Acquired on the Phoenix ICON · infant wide-field retinal image · 1240x1240:
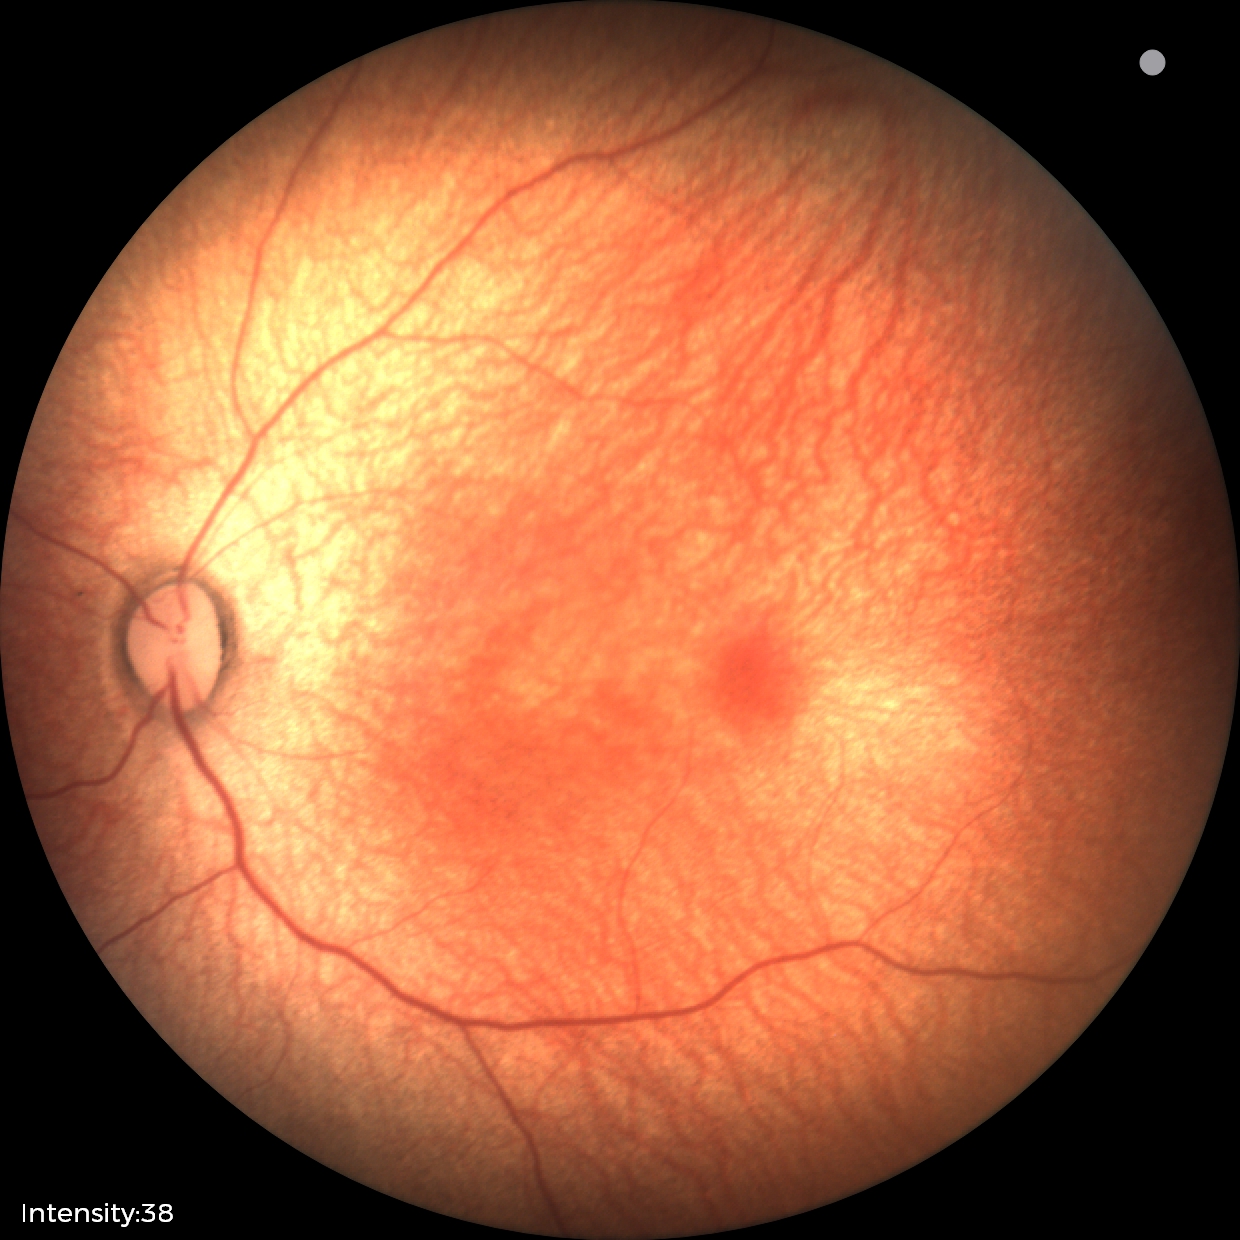

Normal screening examination.